Retinal fundus photograph: 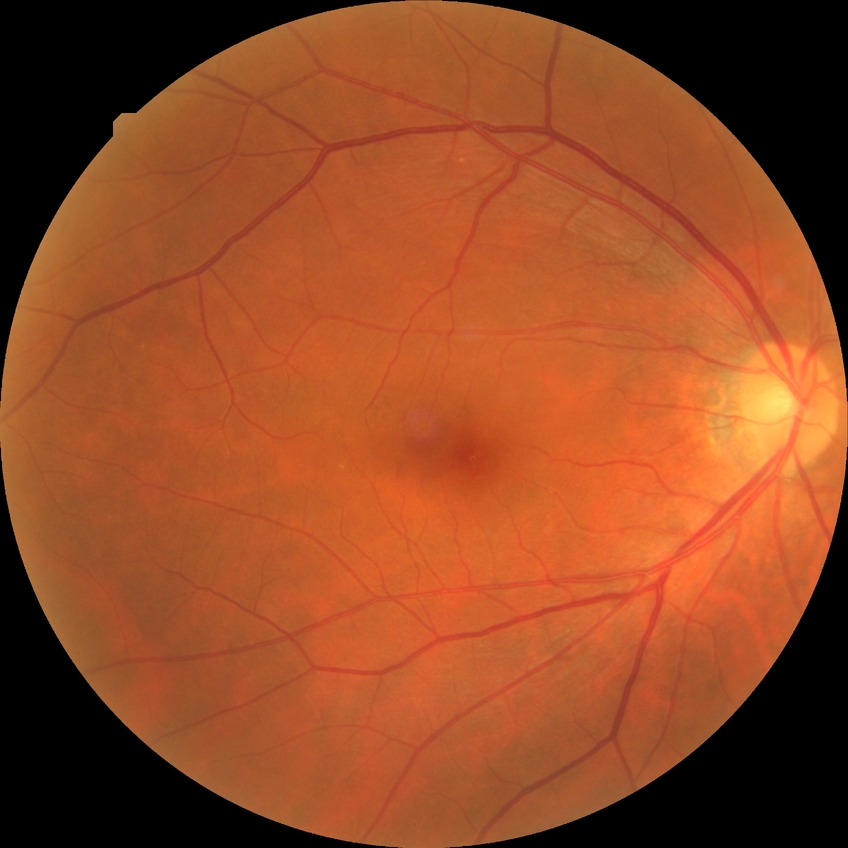
diabetic retinopathy (DR)=NDR (no diabetic retinopathy).